45-degree field of view, 1932 by 1932 pixels
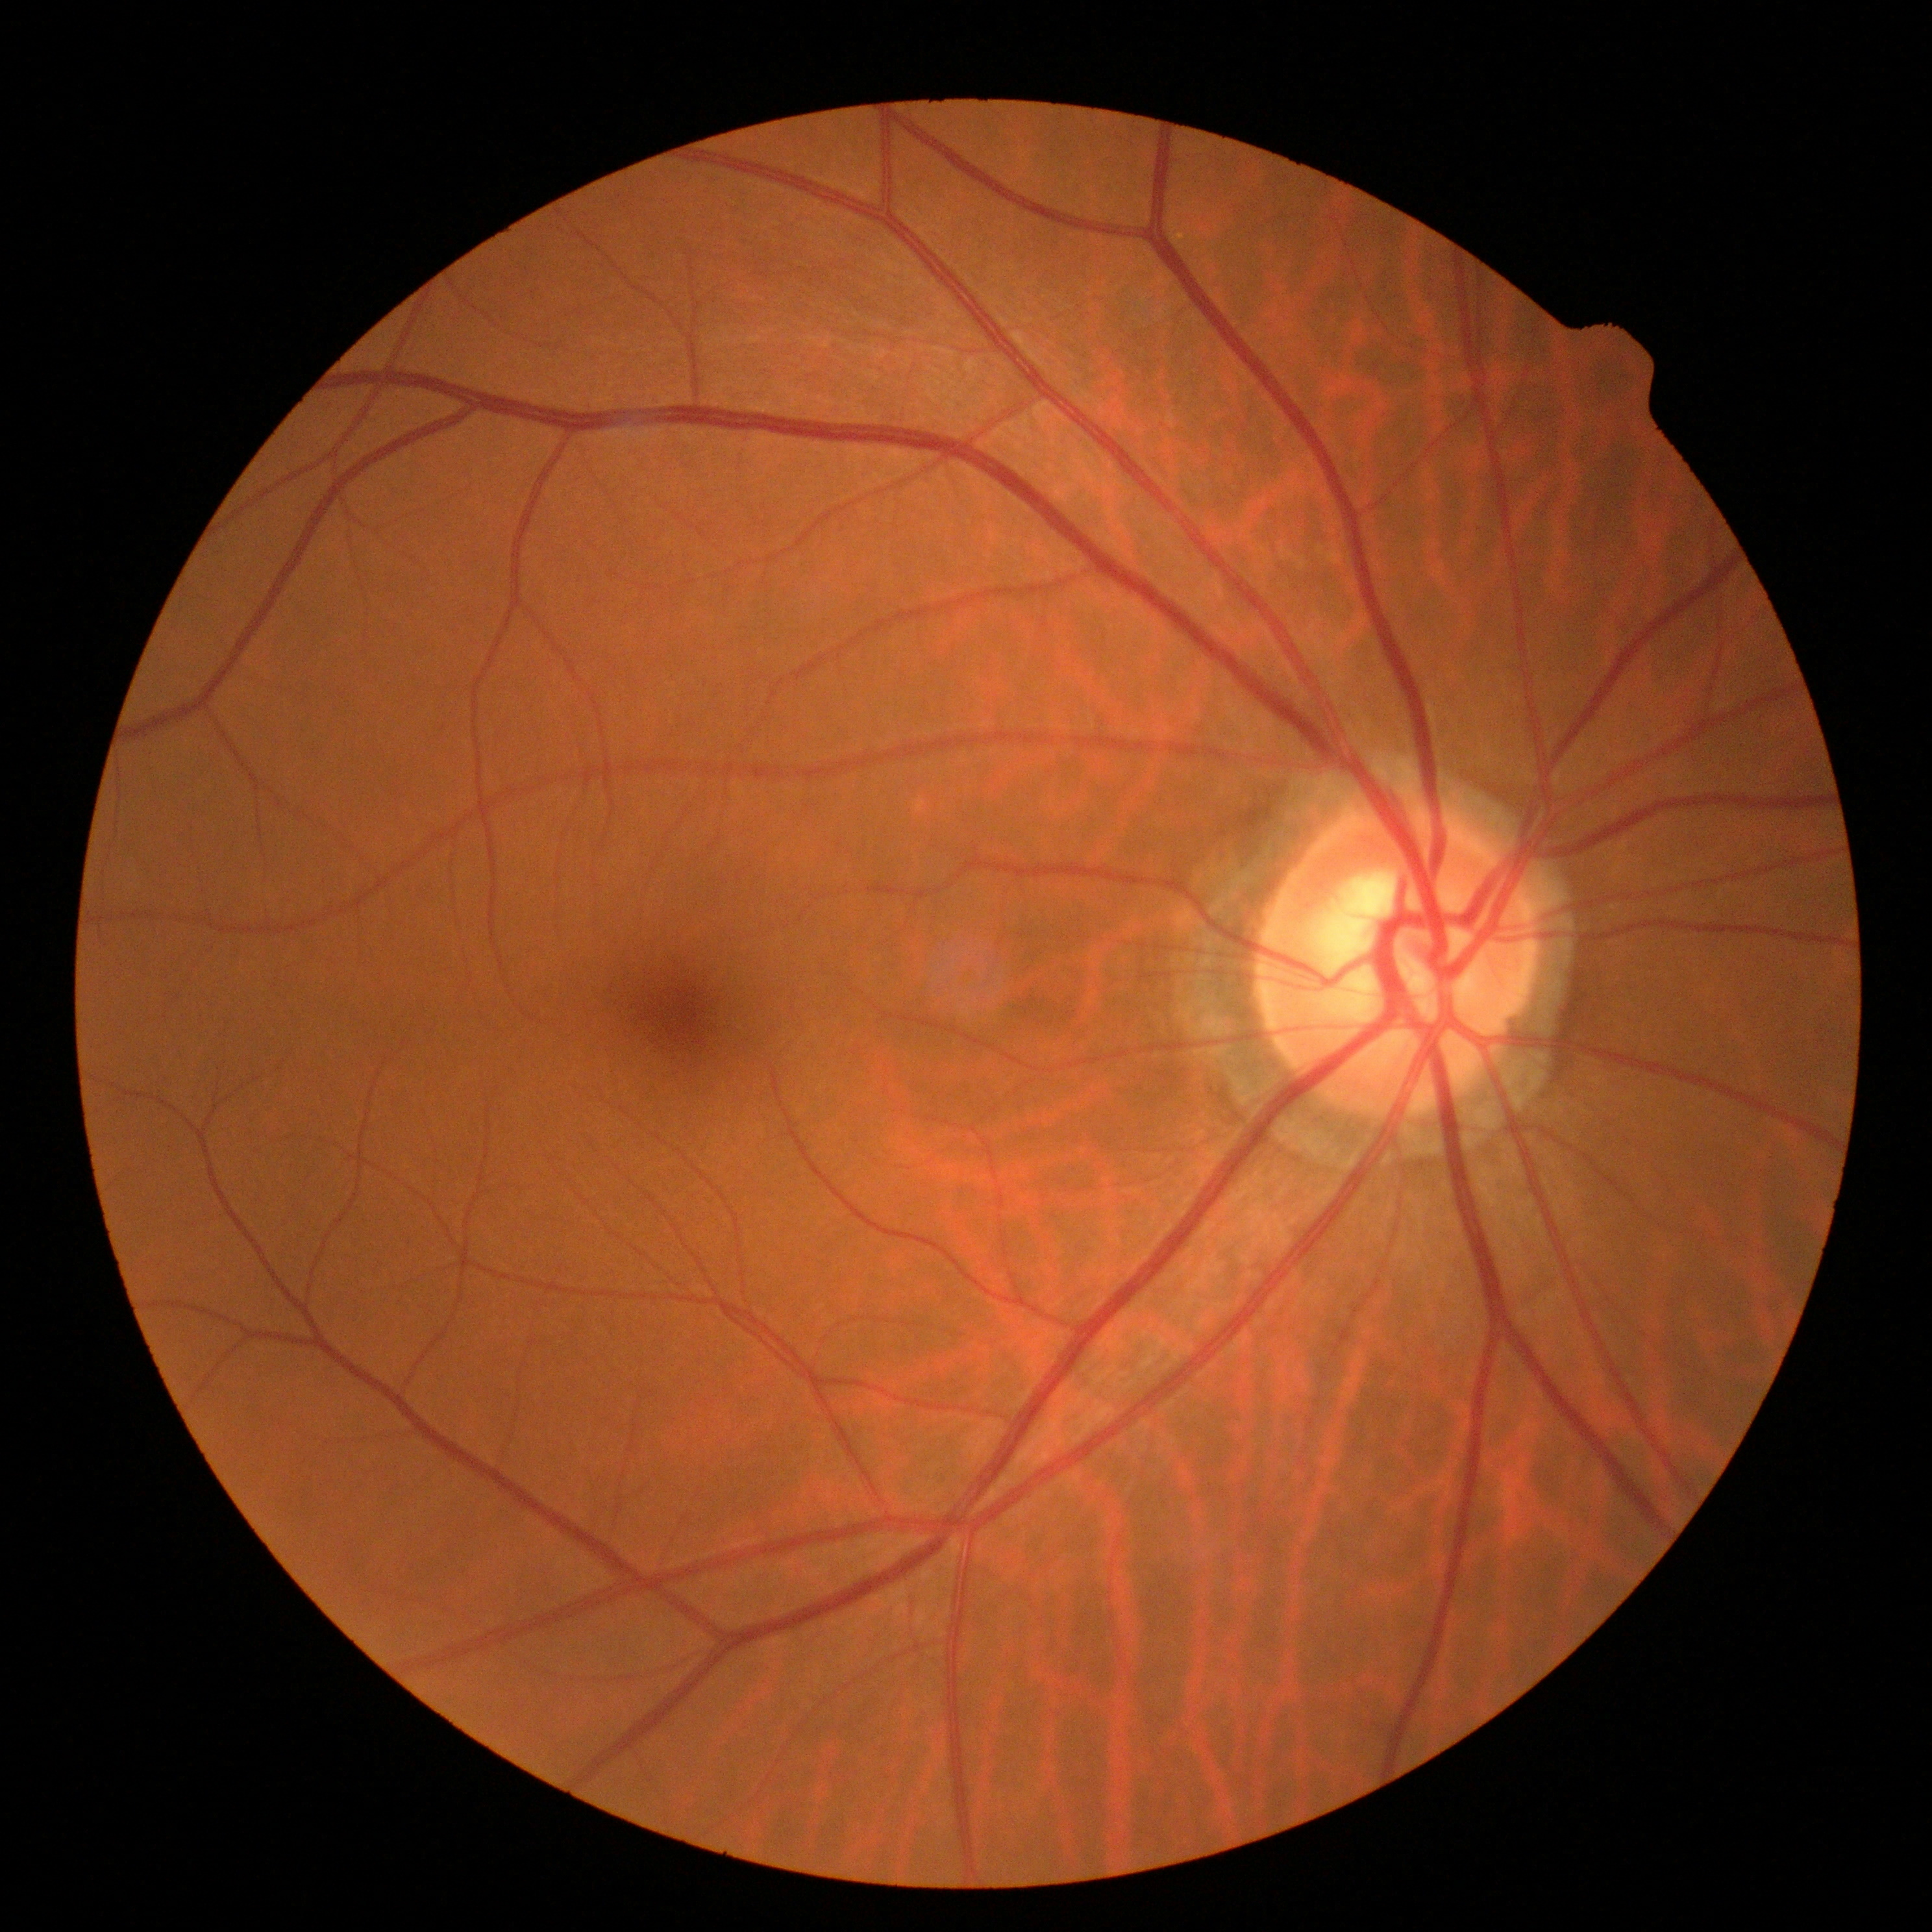 DR = no apparent retinopathy (grade 0).